2352x1568px: 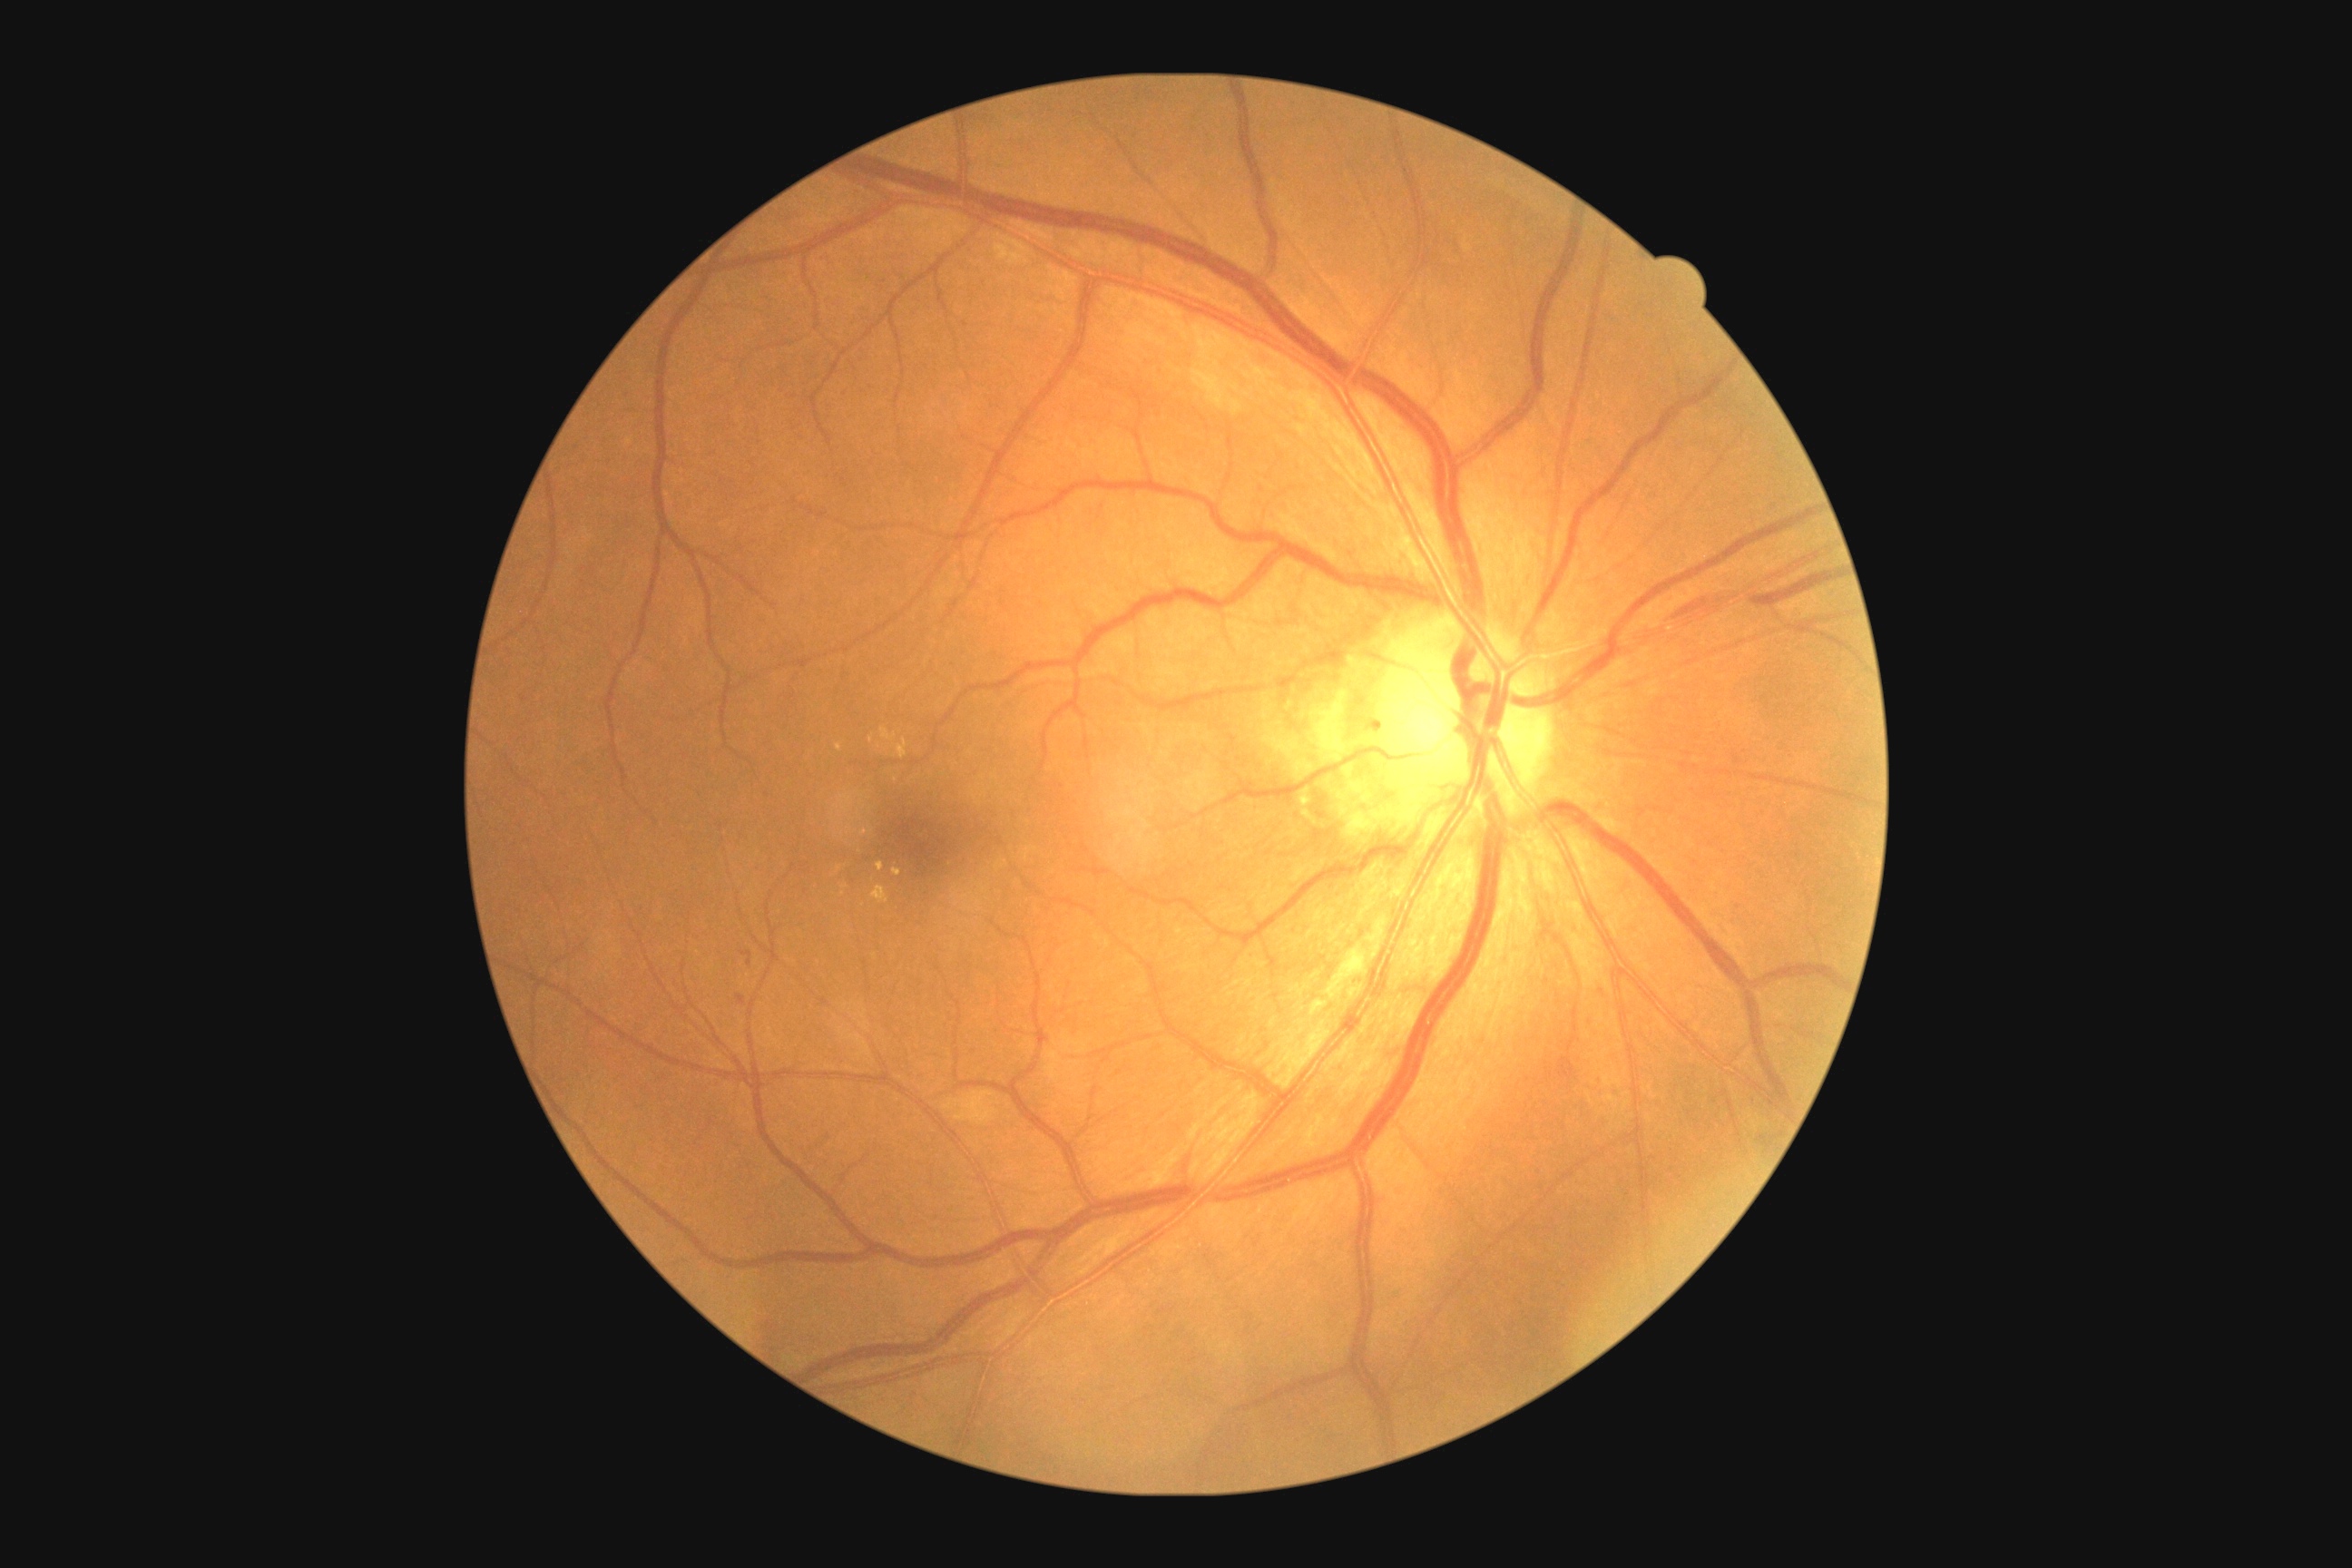
Diabetic retinopathy severity: grade 2 (moderate NPDR).